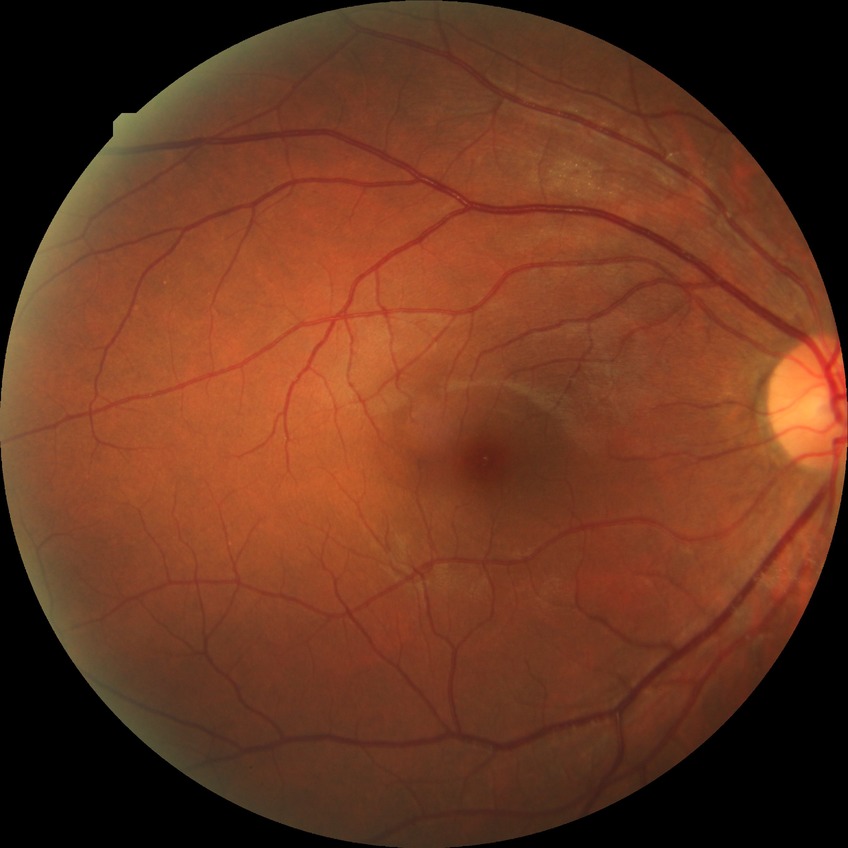 diabetic retinopathy grade: no diabetic retinopathy.